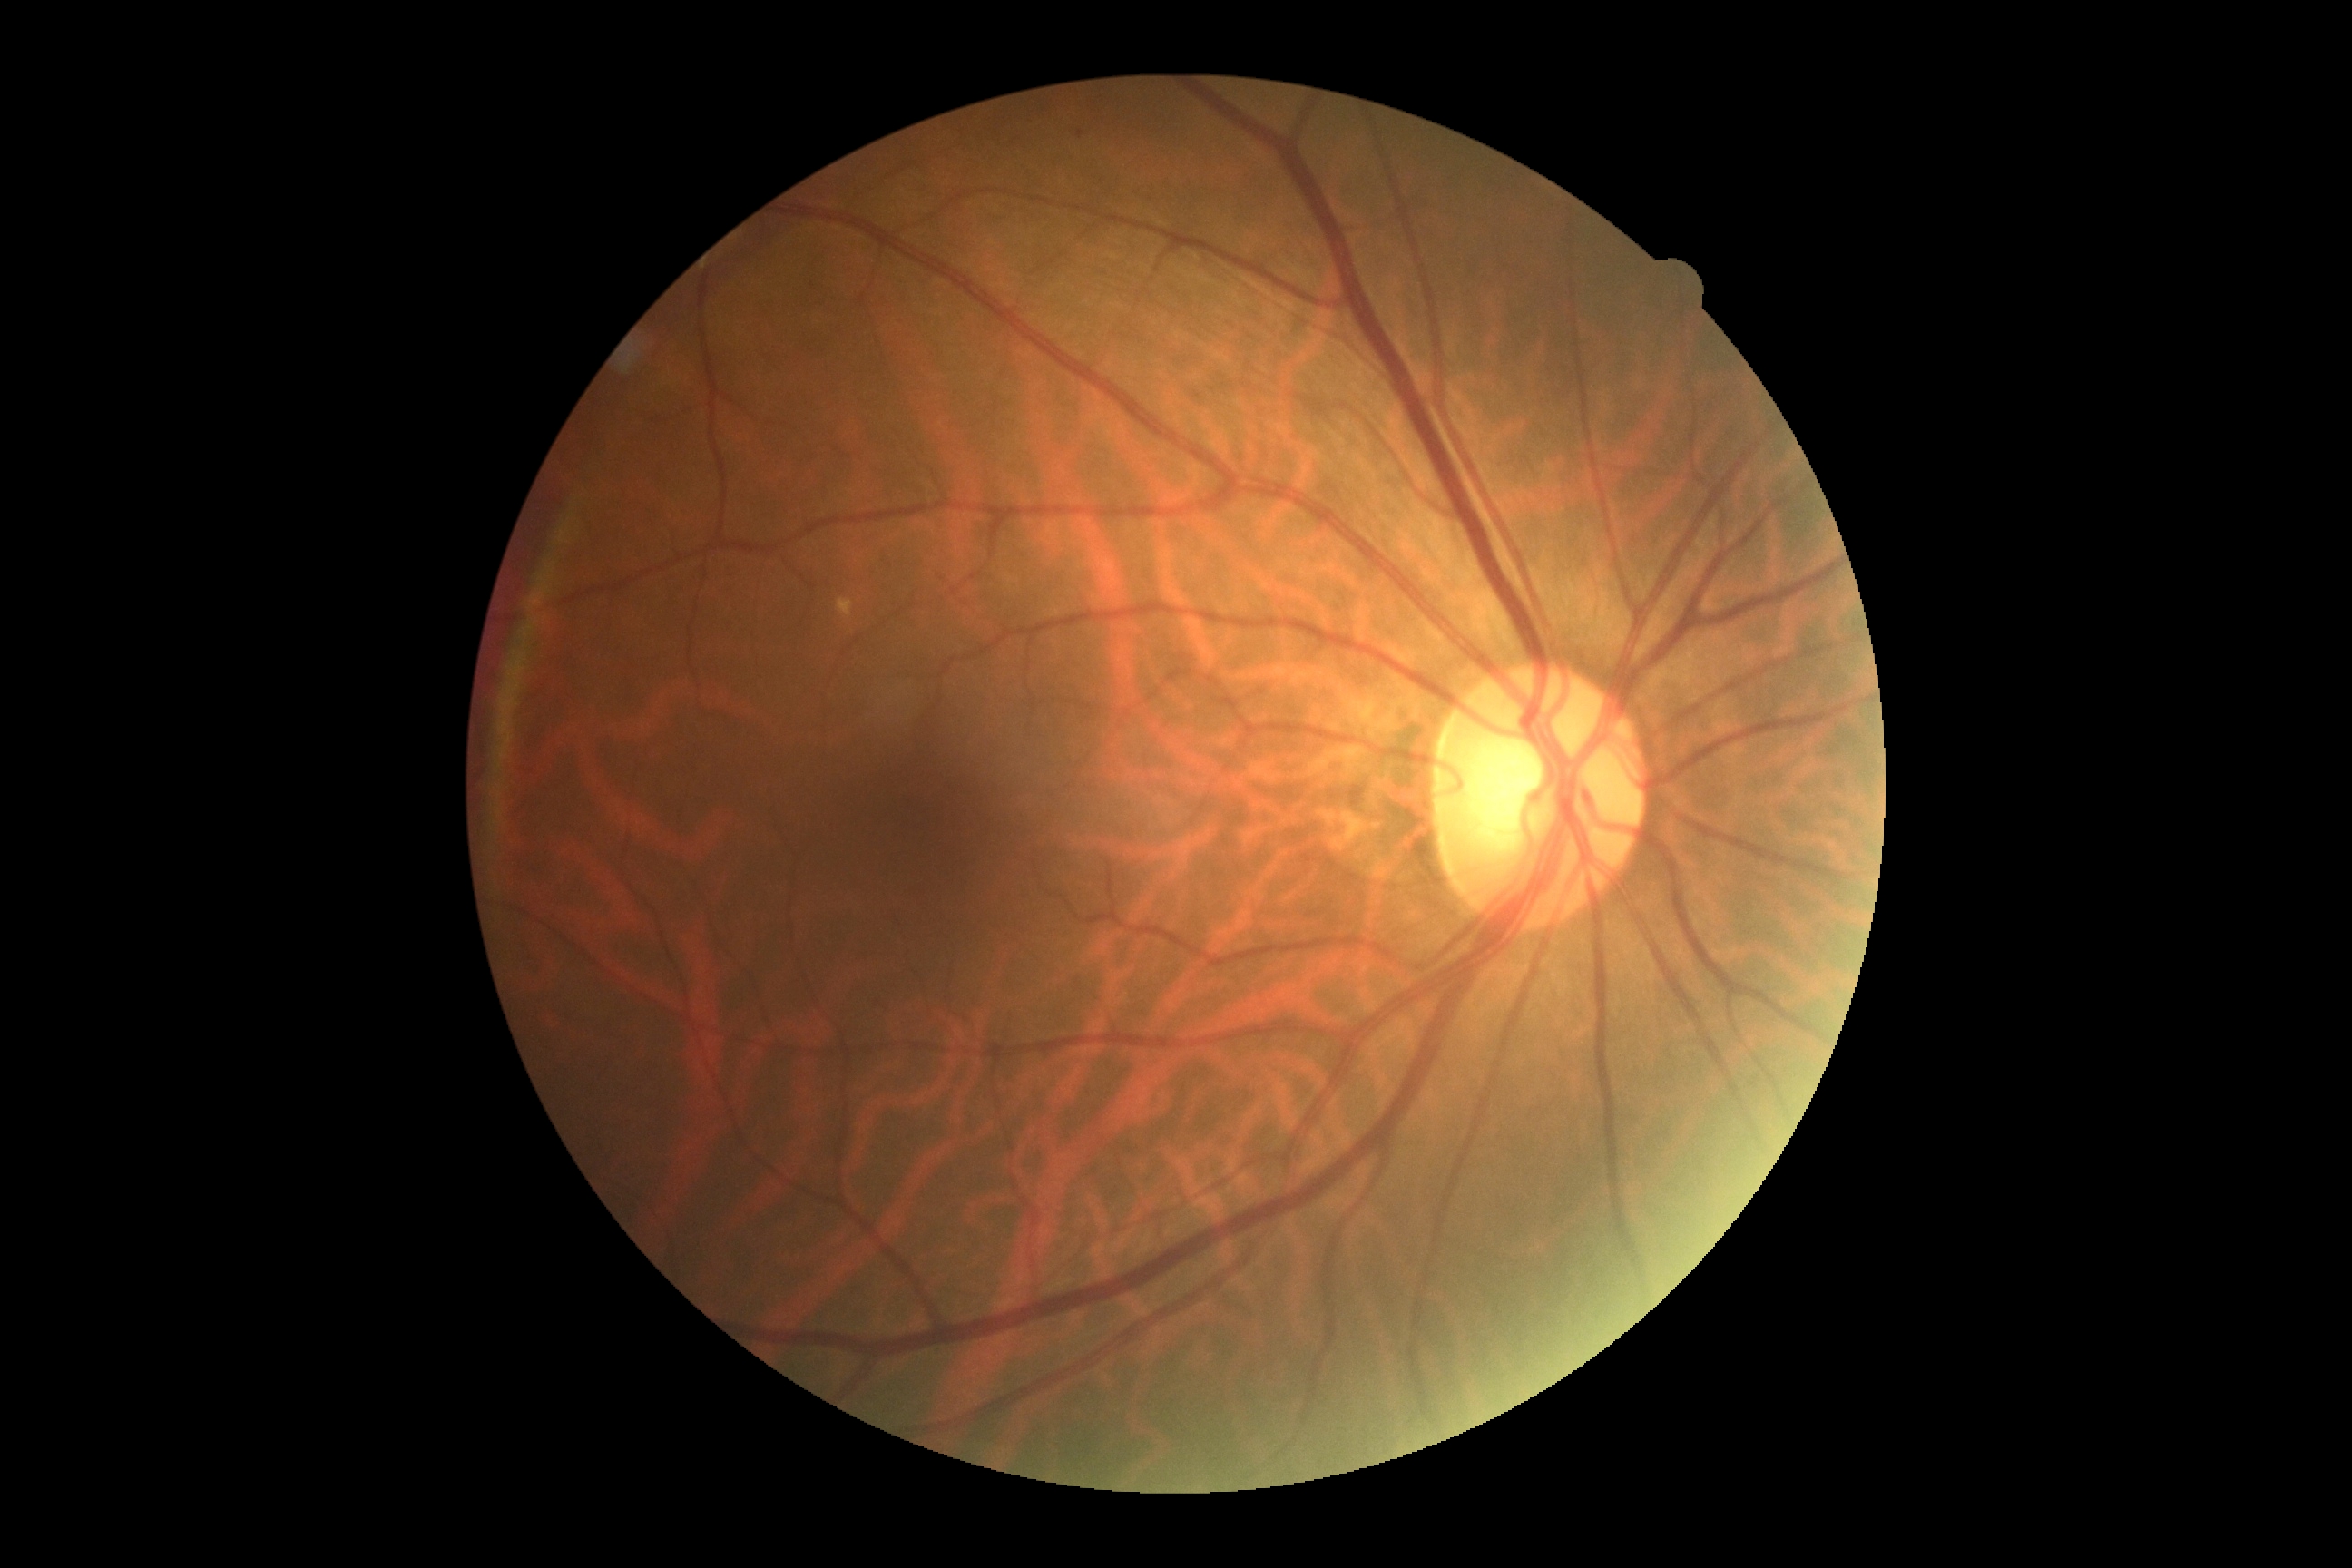

Findings:
• diabetic retinopathy (DR): 0
• DR impression: no apparent DR